RetCam wide-field infant fundus image
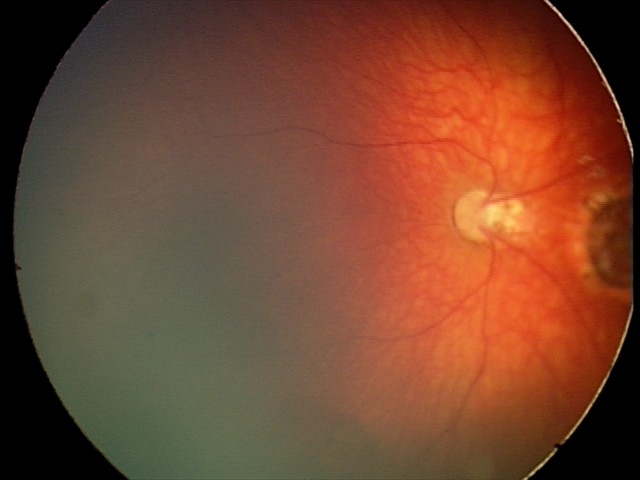
Screening diagnosis: toxoplasmosis chorioretinitis.